Acquired on the Clarity RetCam 3 · wide-field fundus image from infant ROP screening:
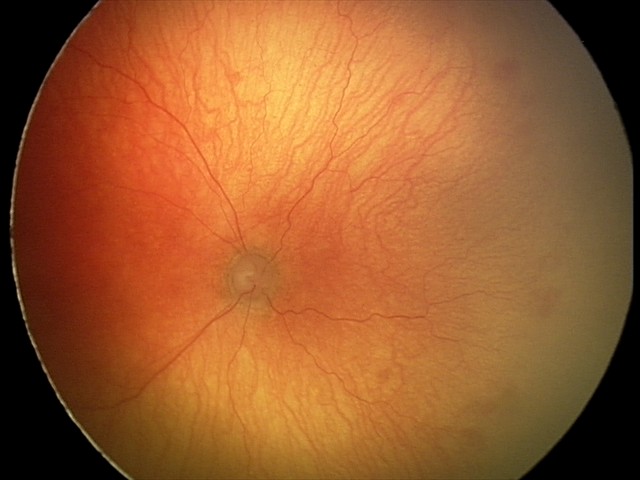
Q: What is the screening diagnosis?
A: aggressive retinopathy of prematurity
Q: What is the plus-form classification?
A: plus disease